Nonmydriatic fundus photograph · 45° FOV
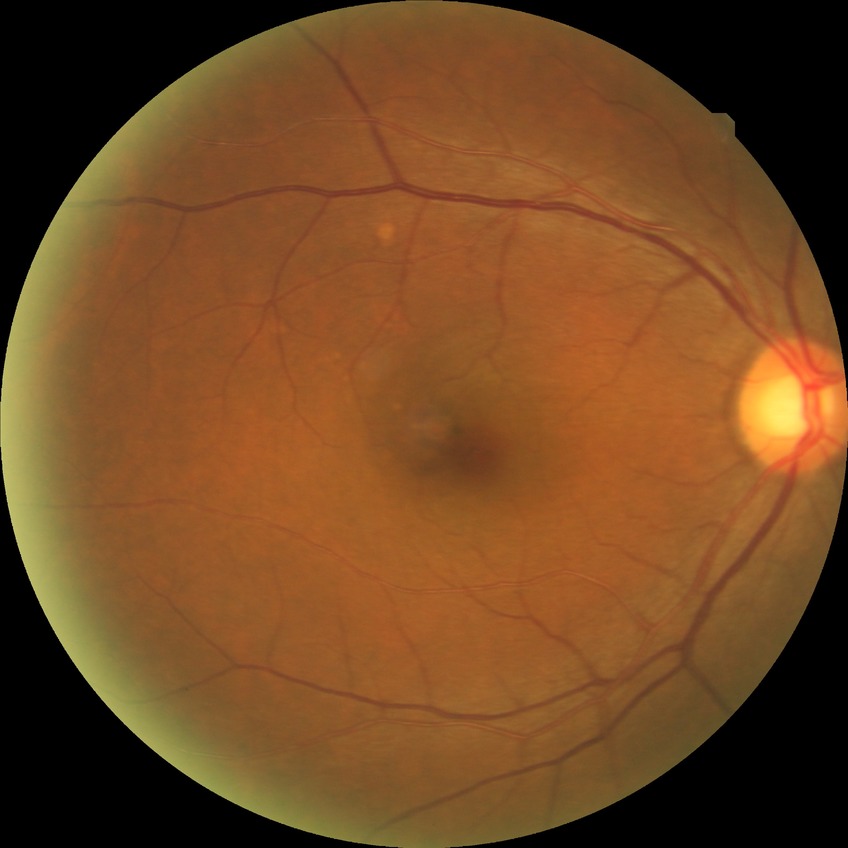 Davis grade: NDR.